Color fundus image. 2048x1536px.
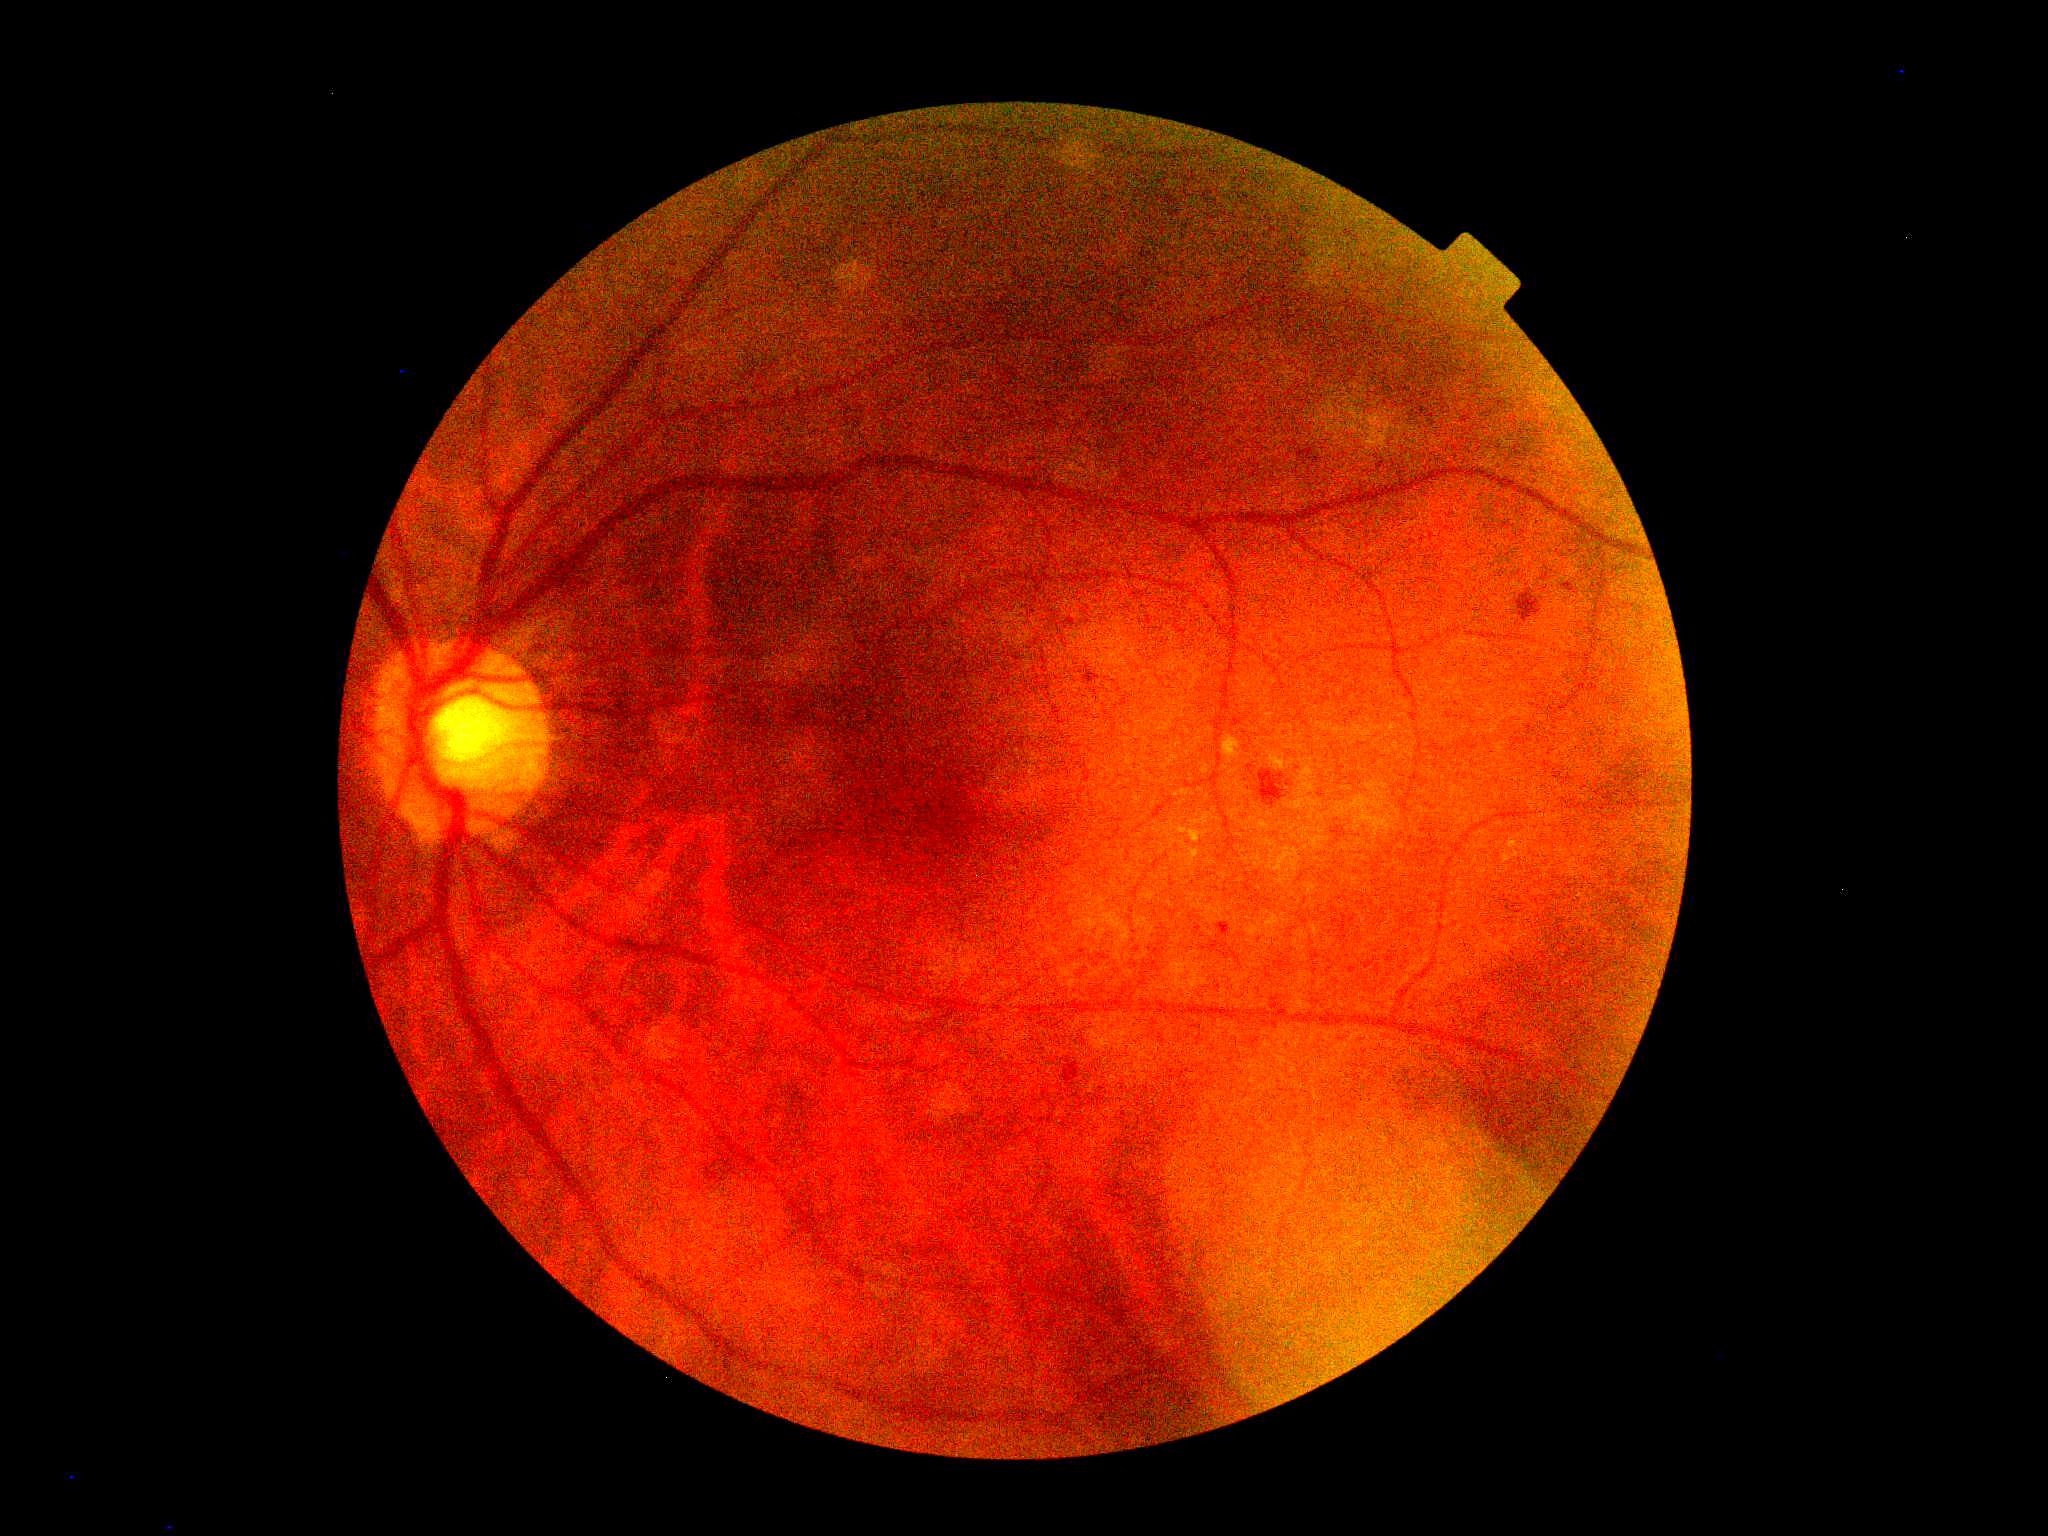

Diabetic retinopathy (DR) is grade 2 (moderate NPDR).